848x848px · posterior pole photograph: 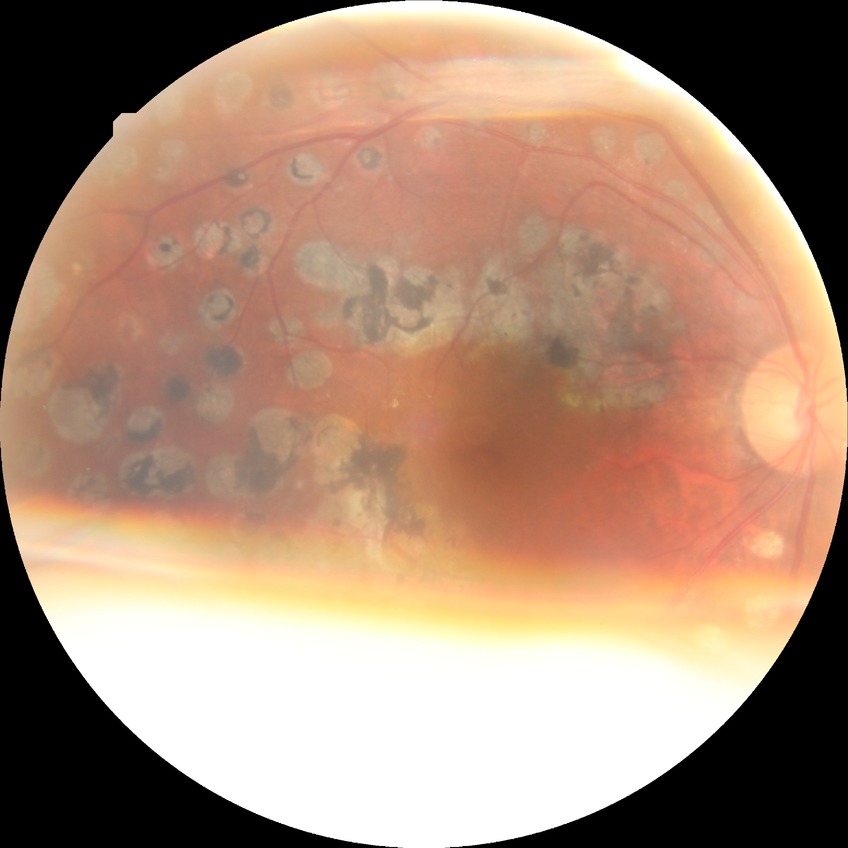 Modified Davis grading: proliferative diabetic retinopathy.